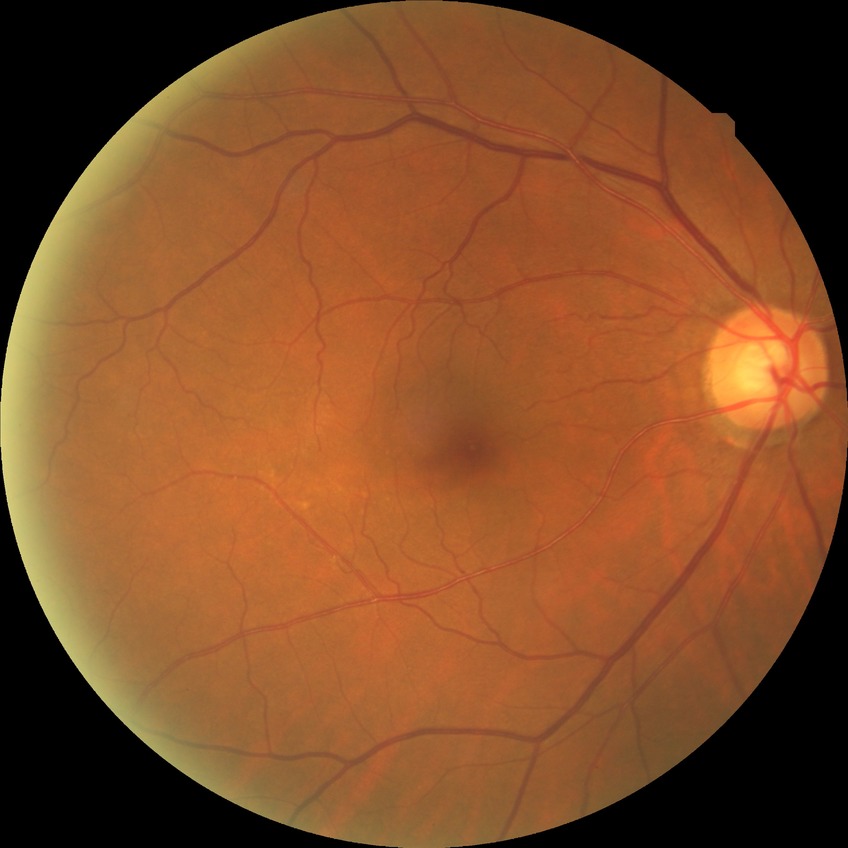 Diabetic retinopathy severity: no diabetic retinopathy.